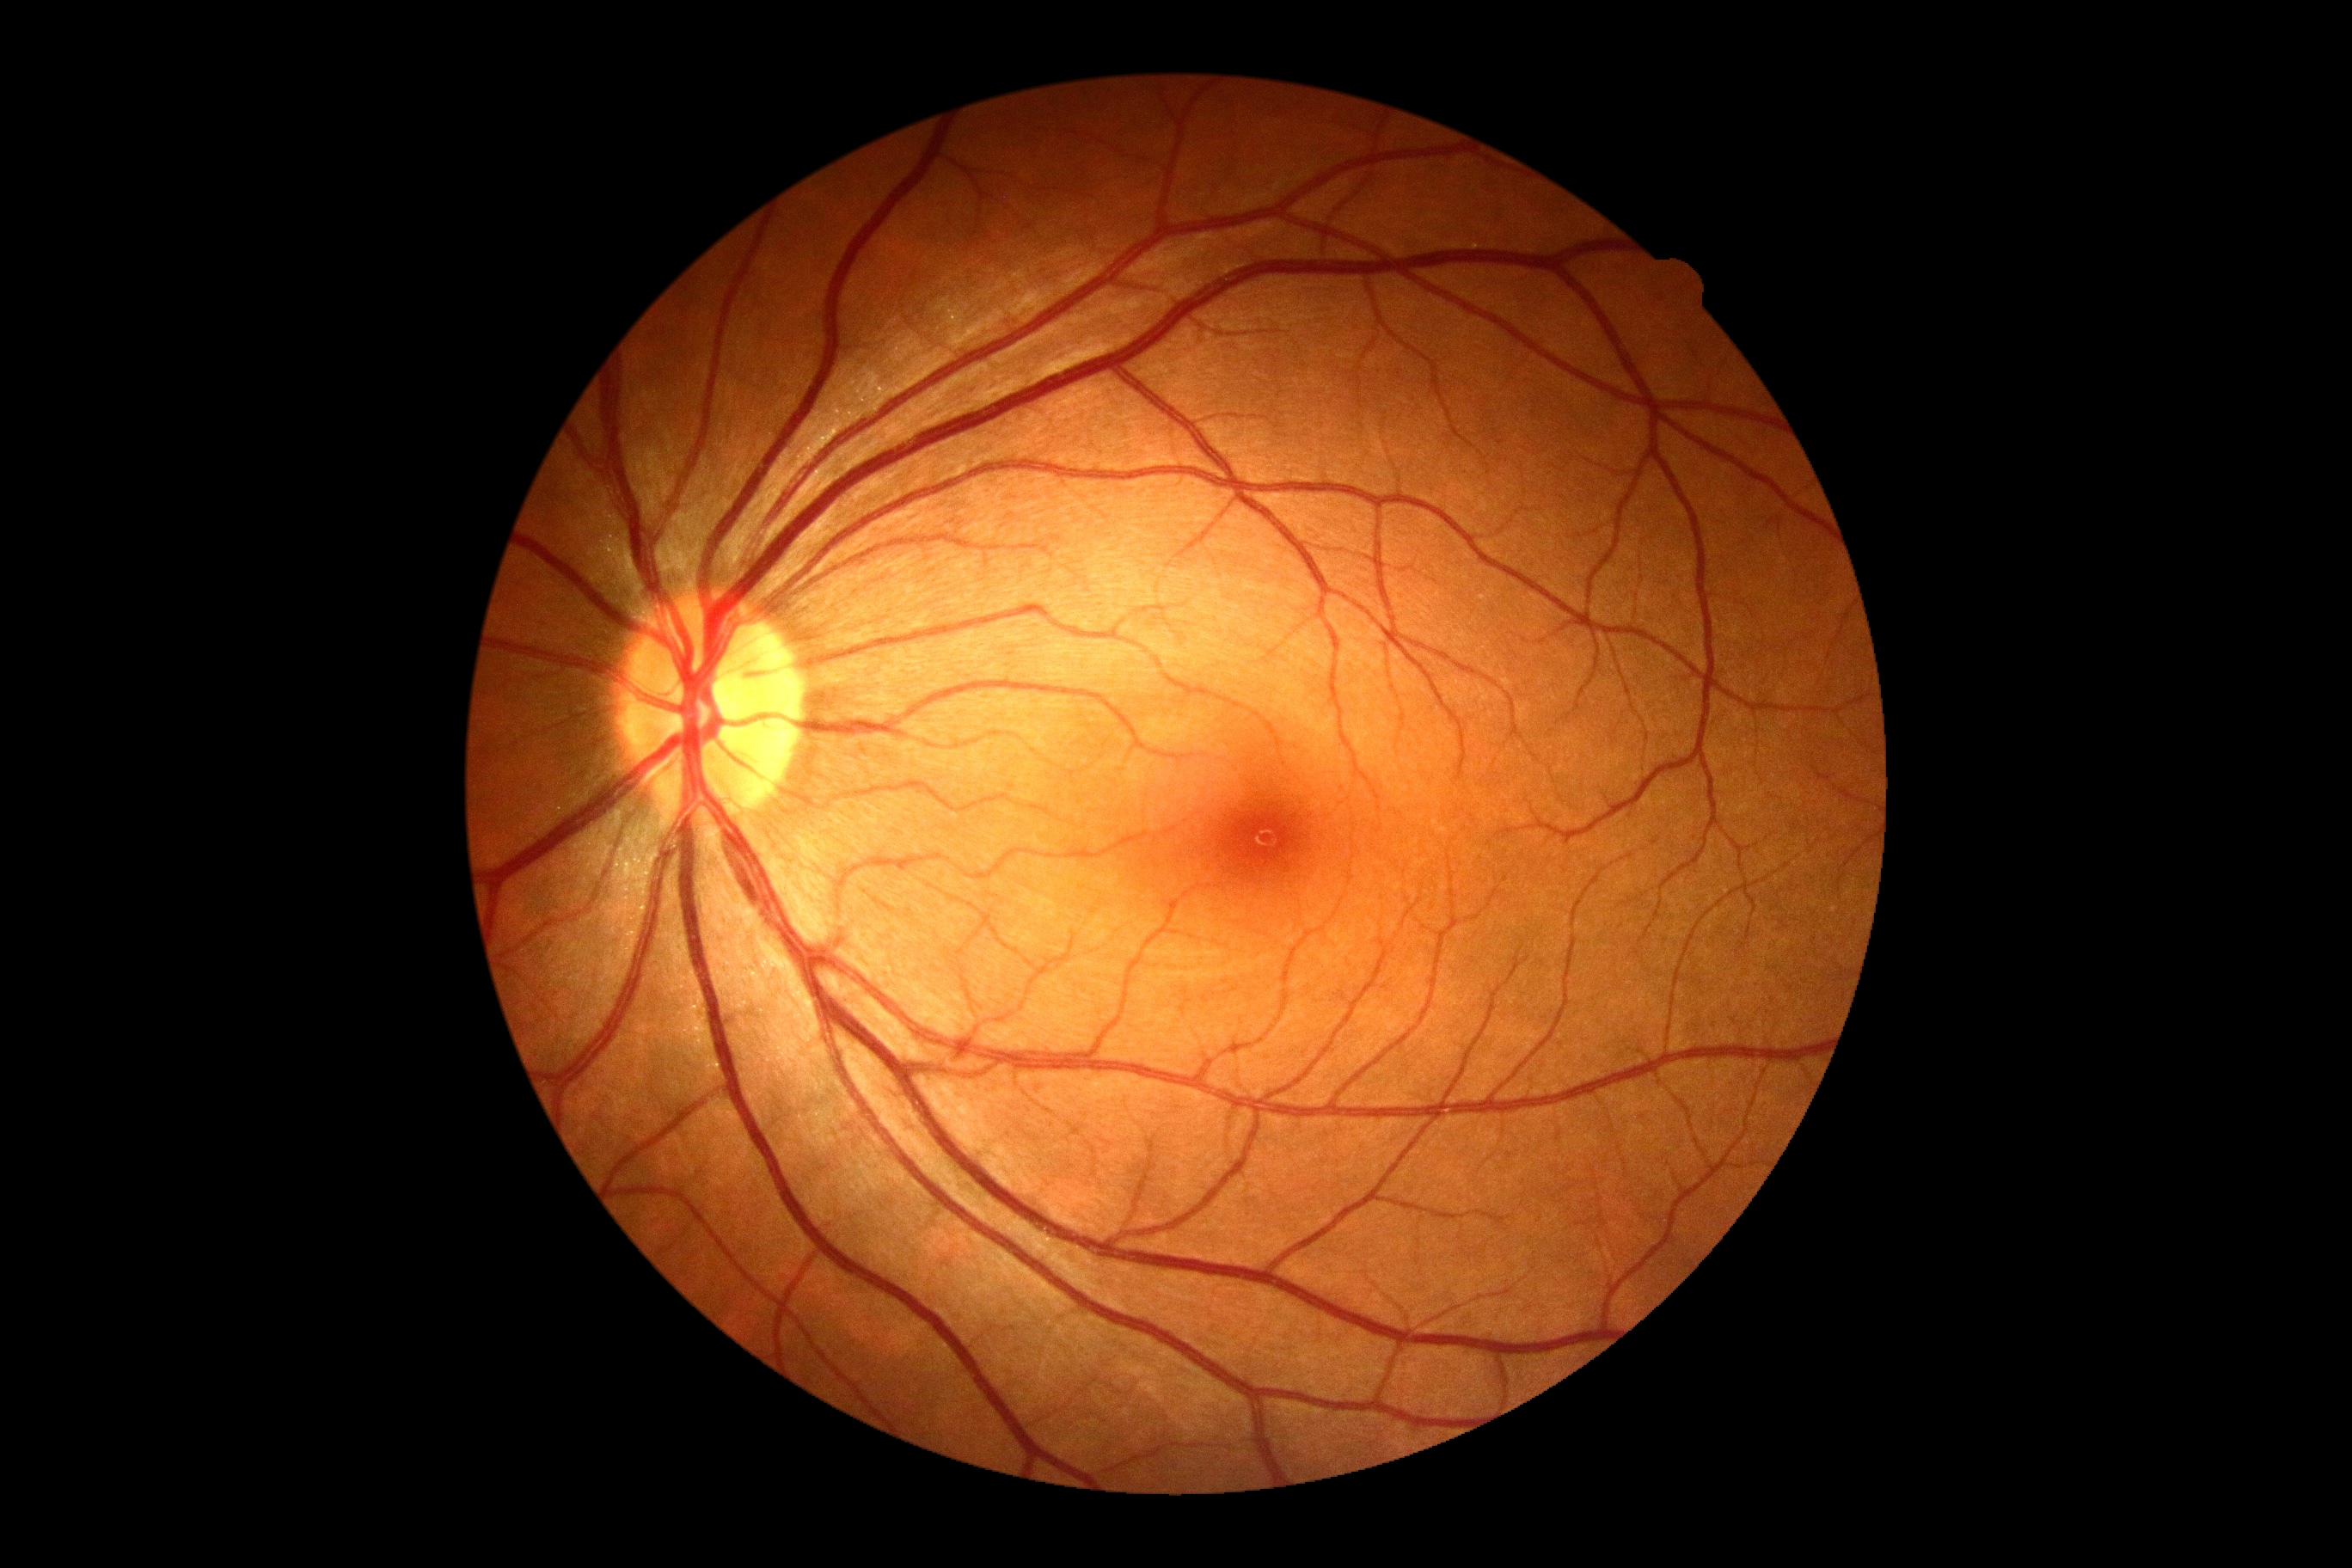

dr_grade: grade 0 (no apparent retinopathy)